45° FOV
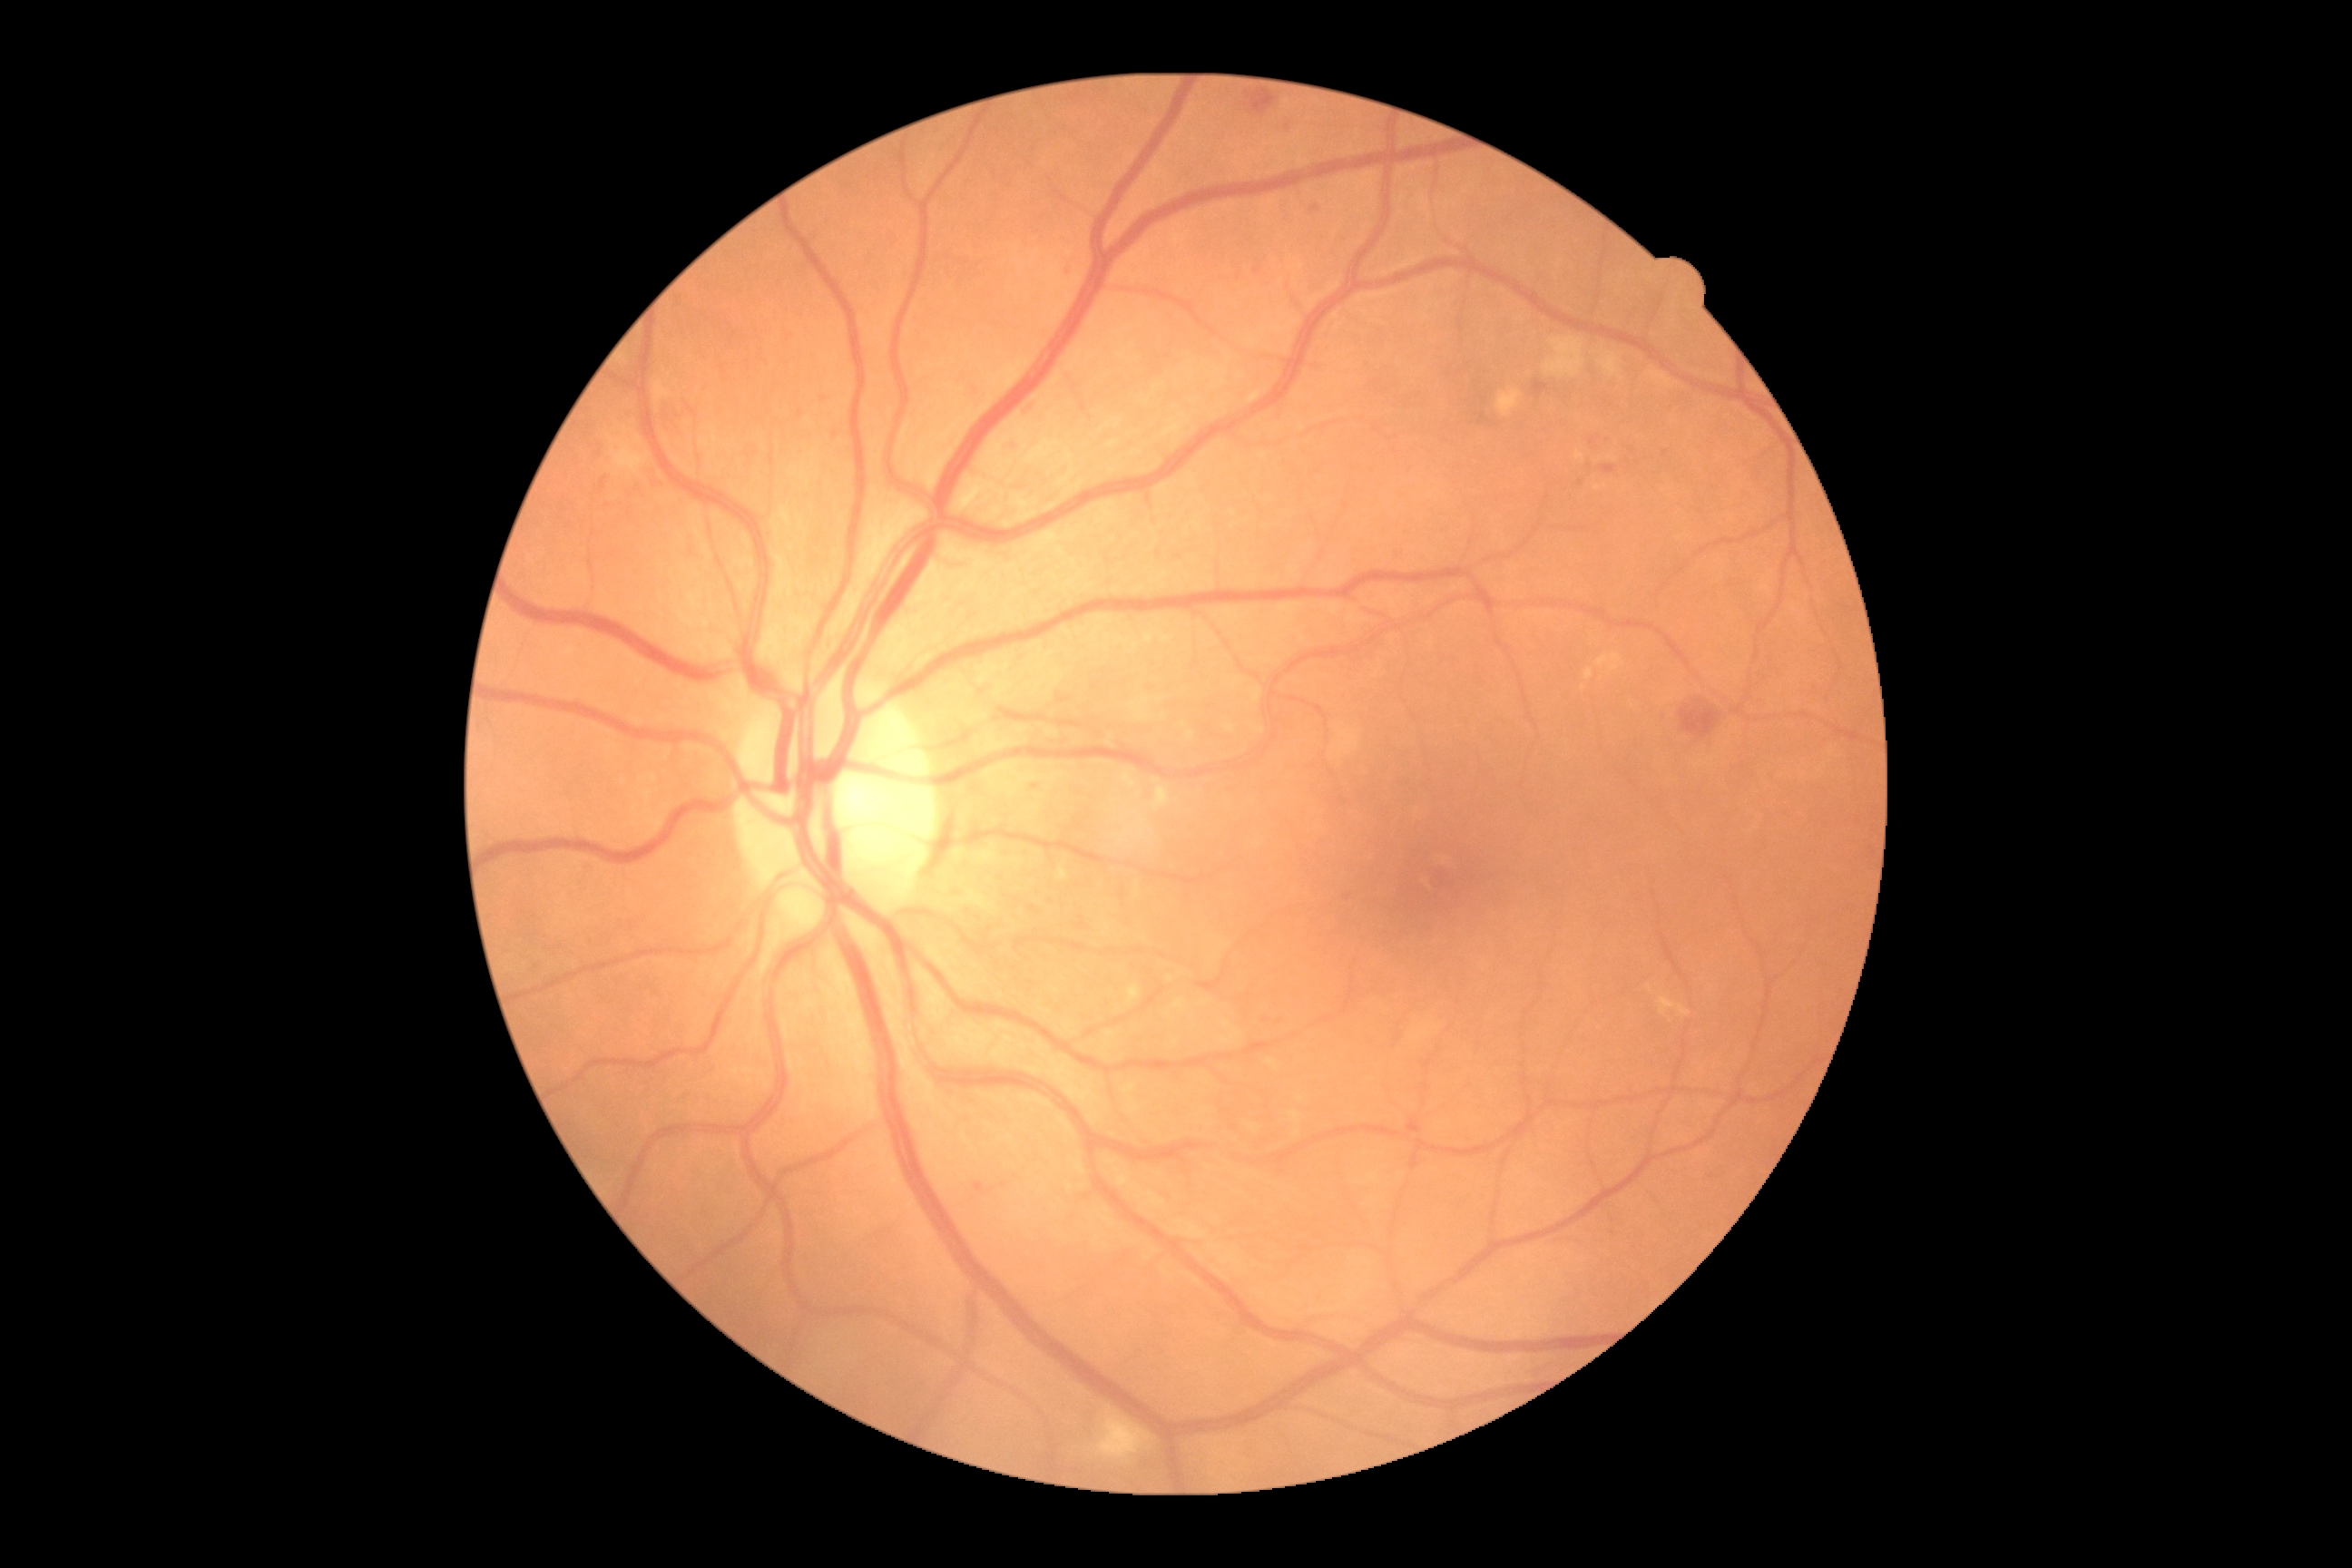

Retinopathy grade: 2 — more than just microaneurysms but less than severe NPDR.
The retinopathy is classified as non-proliferative diabetic retinopathy.